Pediatric retinal photograph (wide-field):
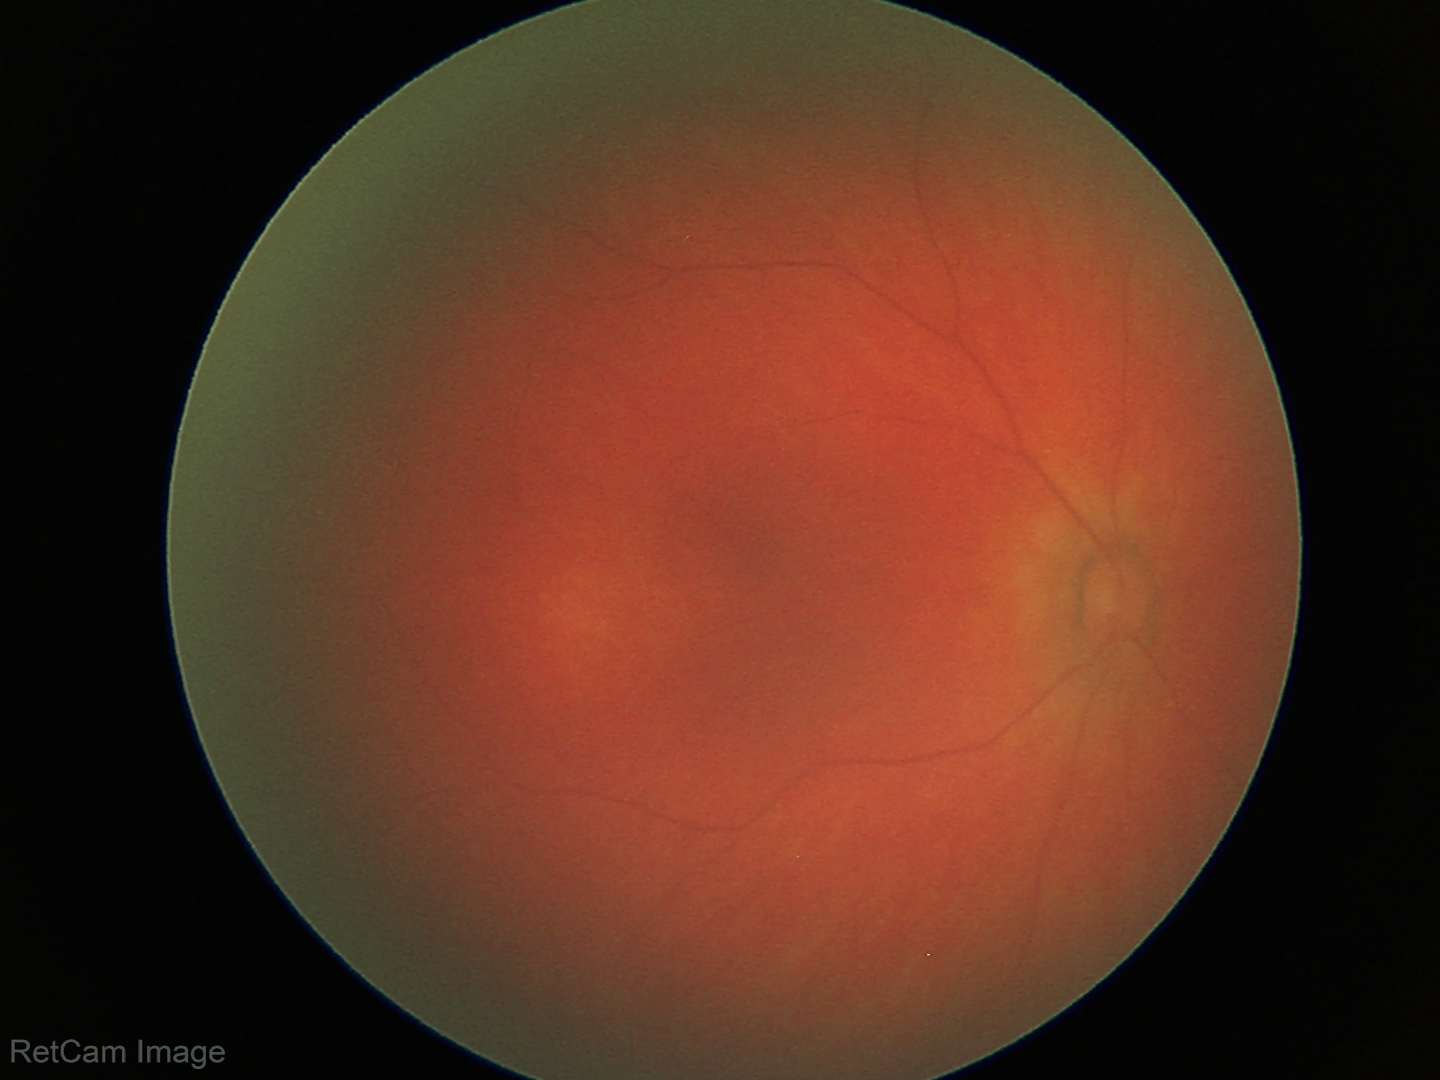

Q: What was the screening finding?
A: physiological retinal finding